2048 by 1536 pixels:
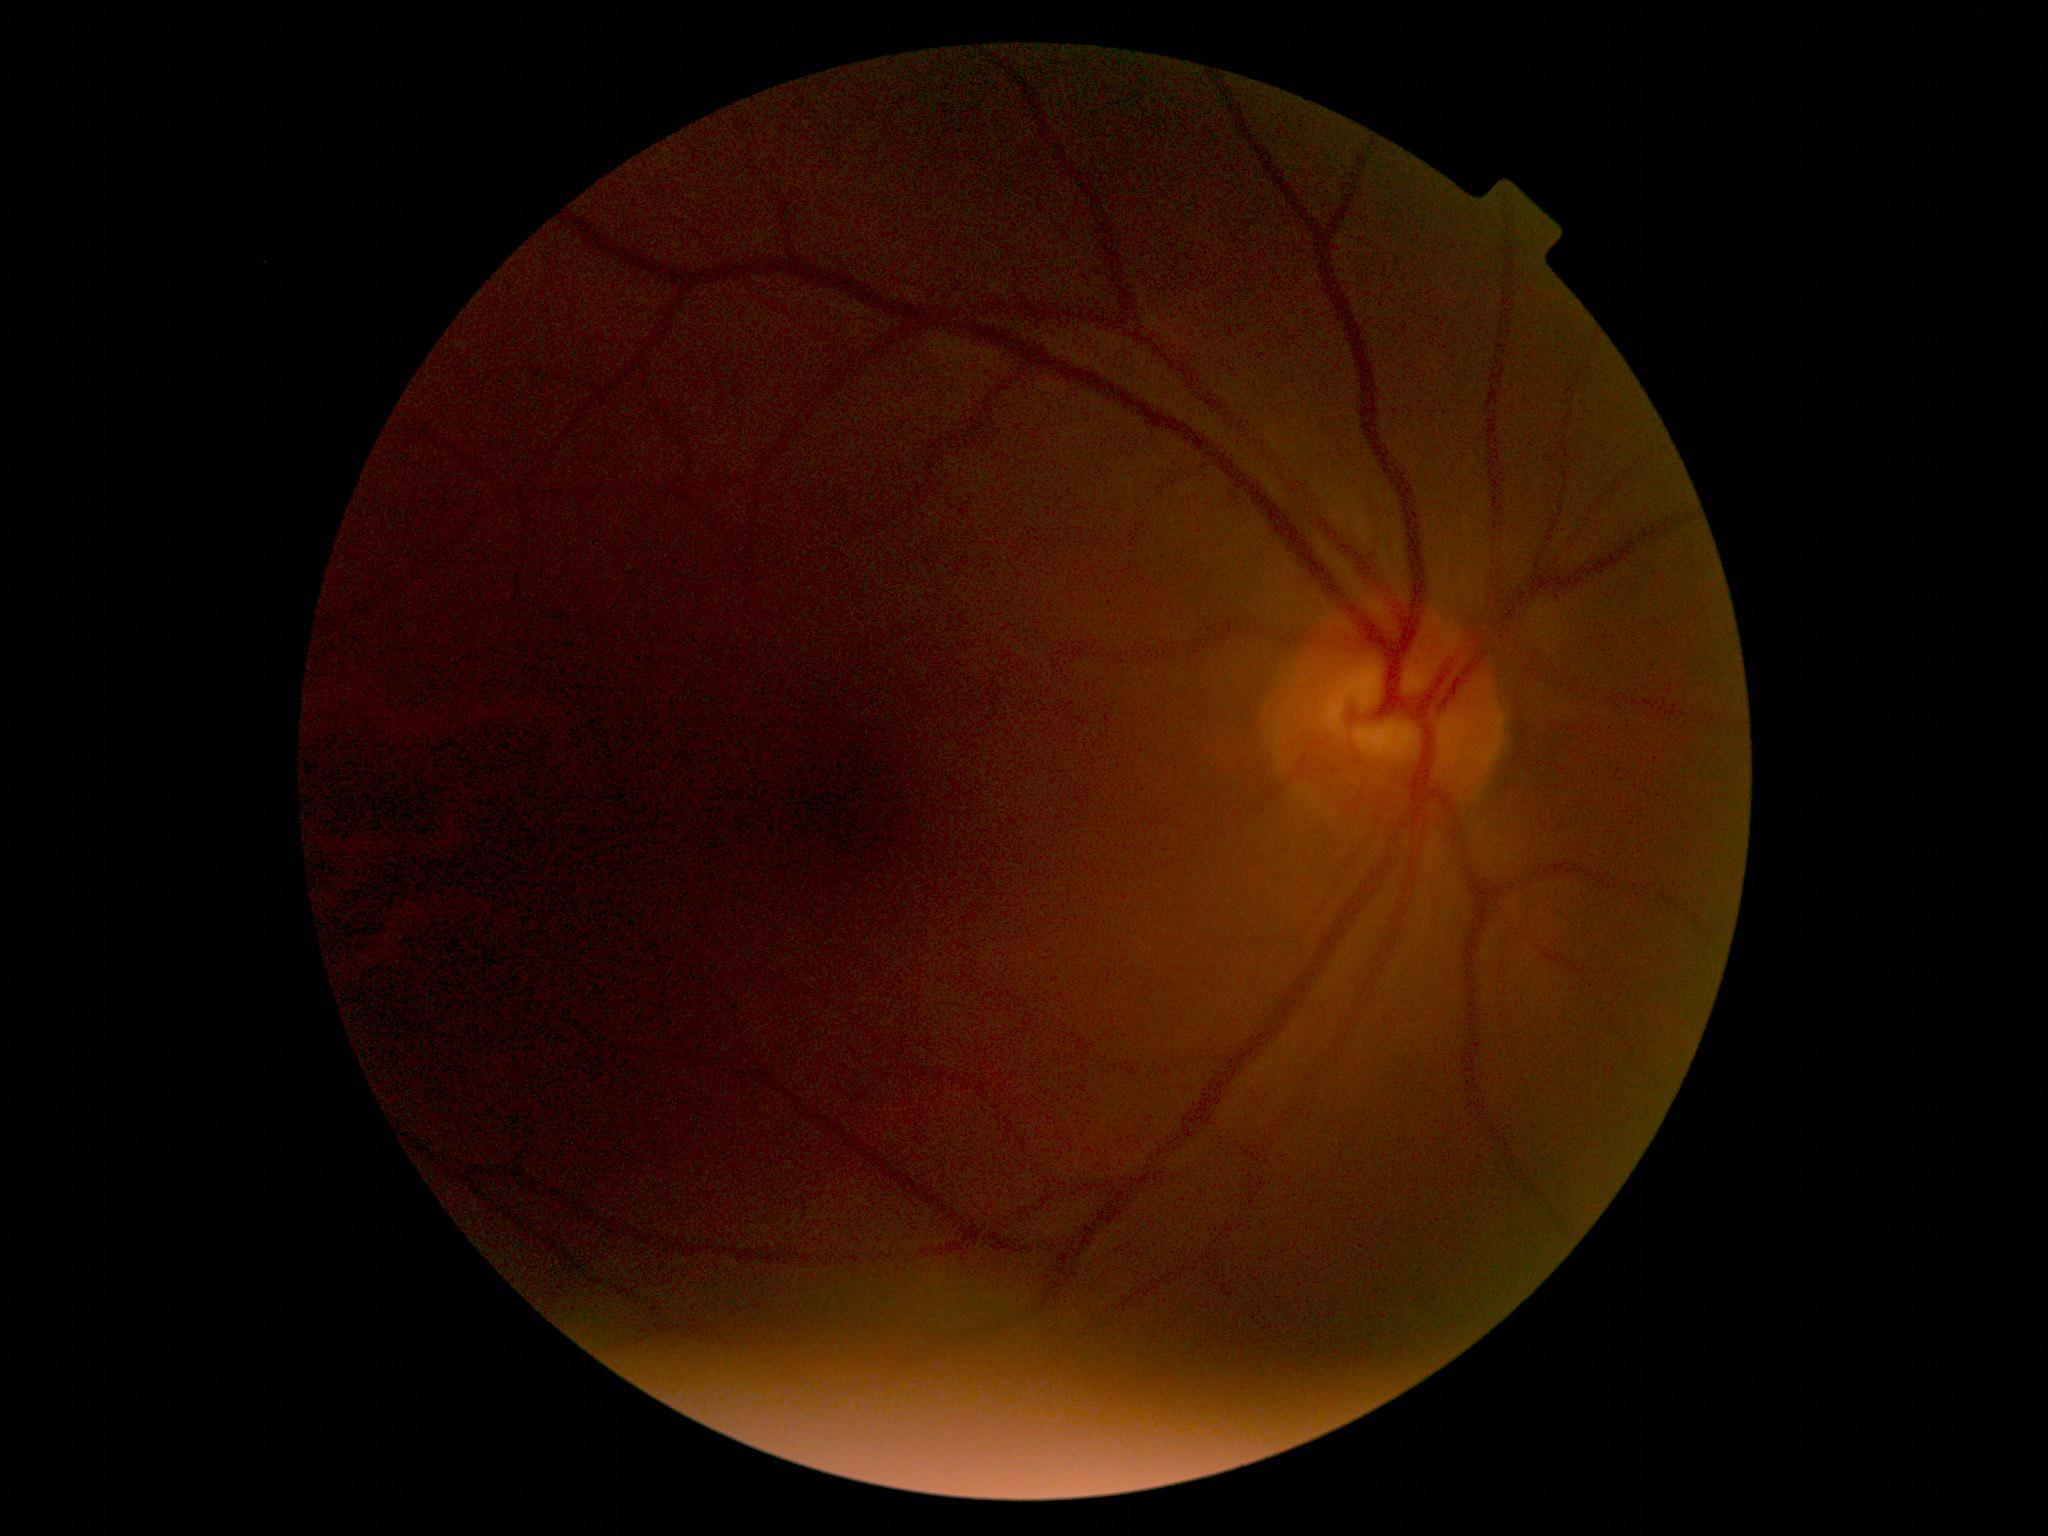 DR is no apparent diabetic retinopathy (grade 0).
No diabetic retinal disease findings.